45-degree field of view · color fundus image.
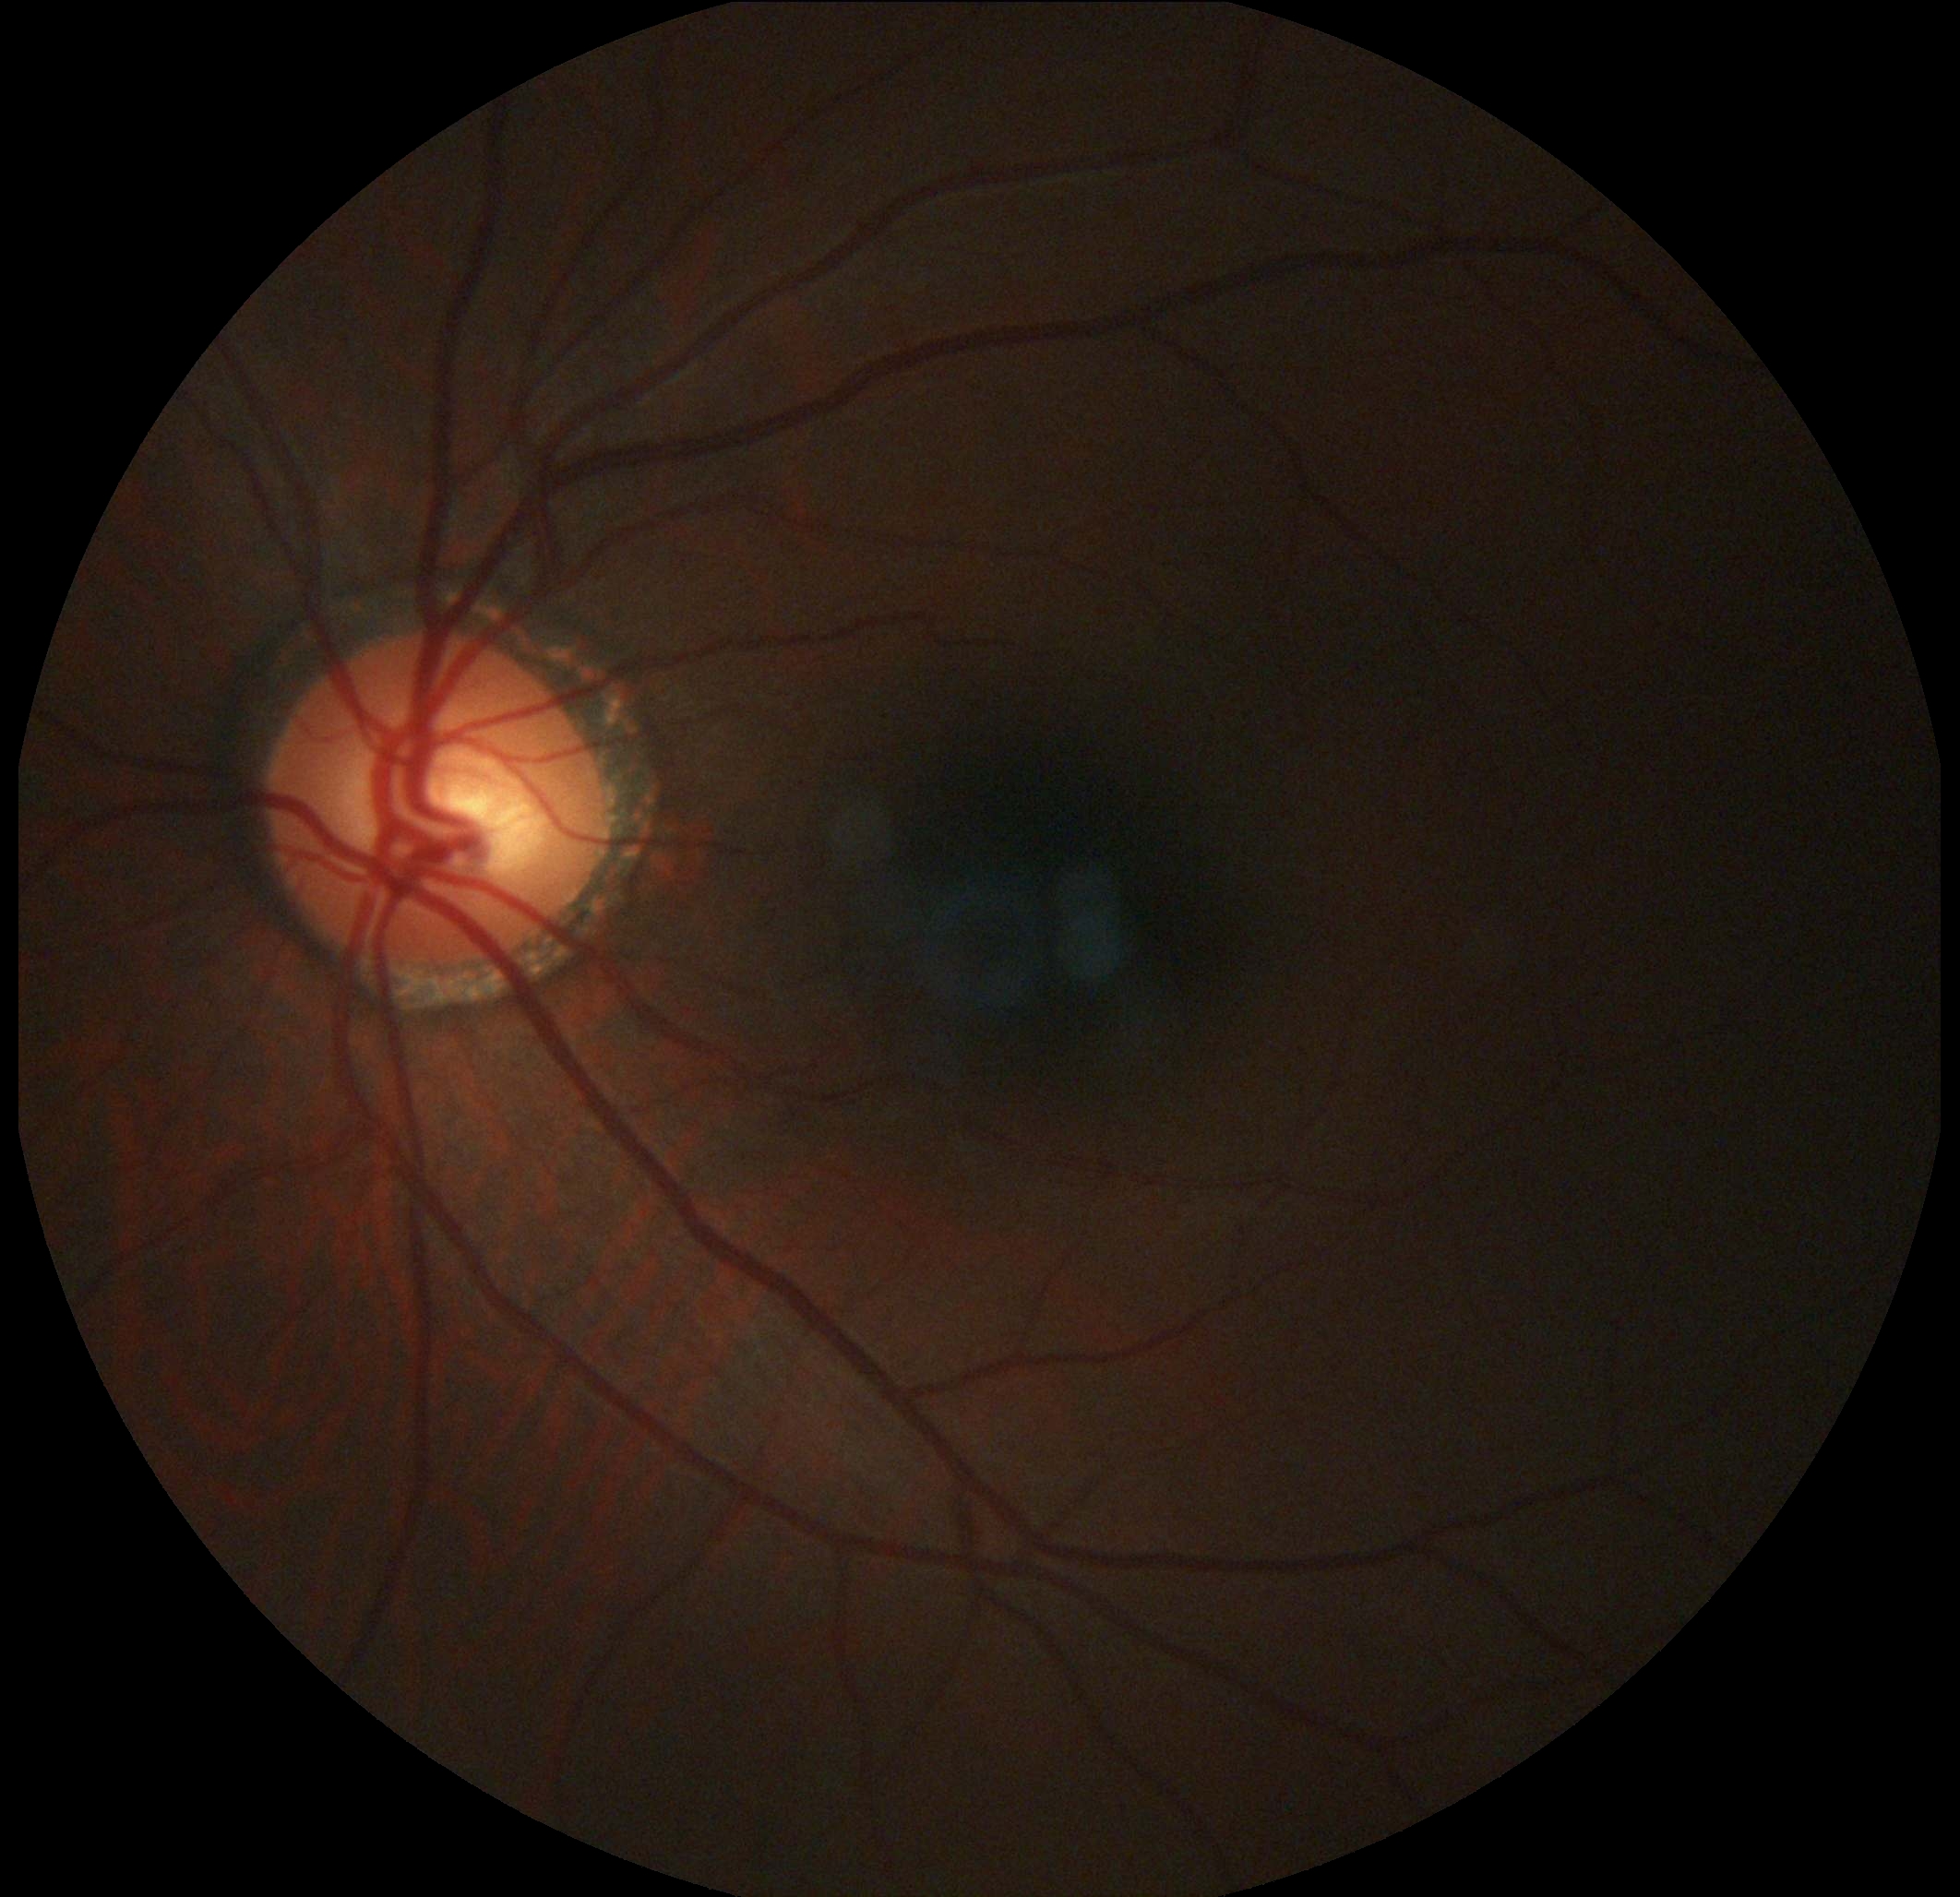
{"dr_grade": "grade 0 (no apparent retinopathy)"}